Image size 1240x1240. Infant wide-field fundus photograph. Acquired on the Phoenix ICON — 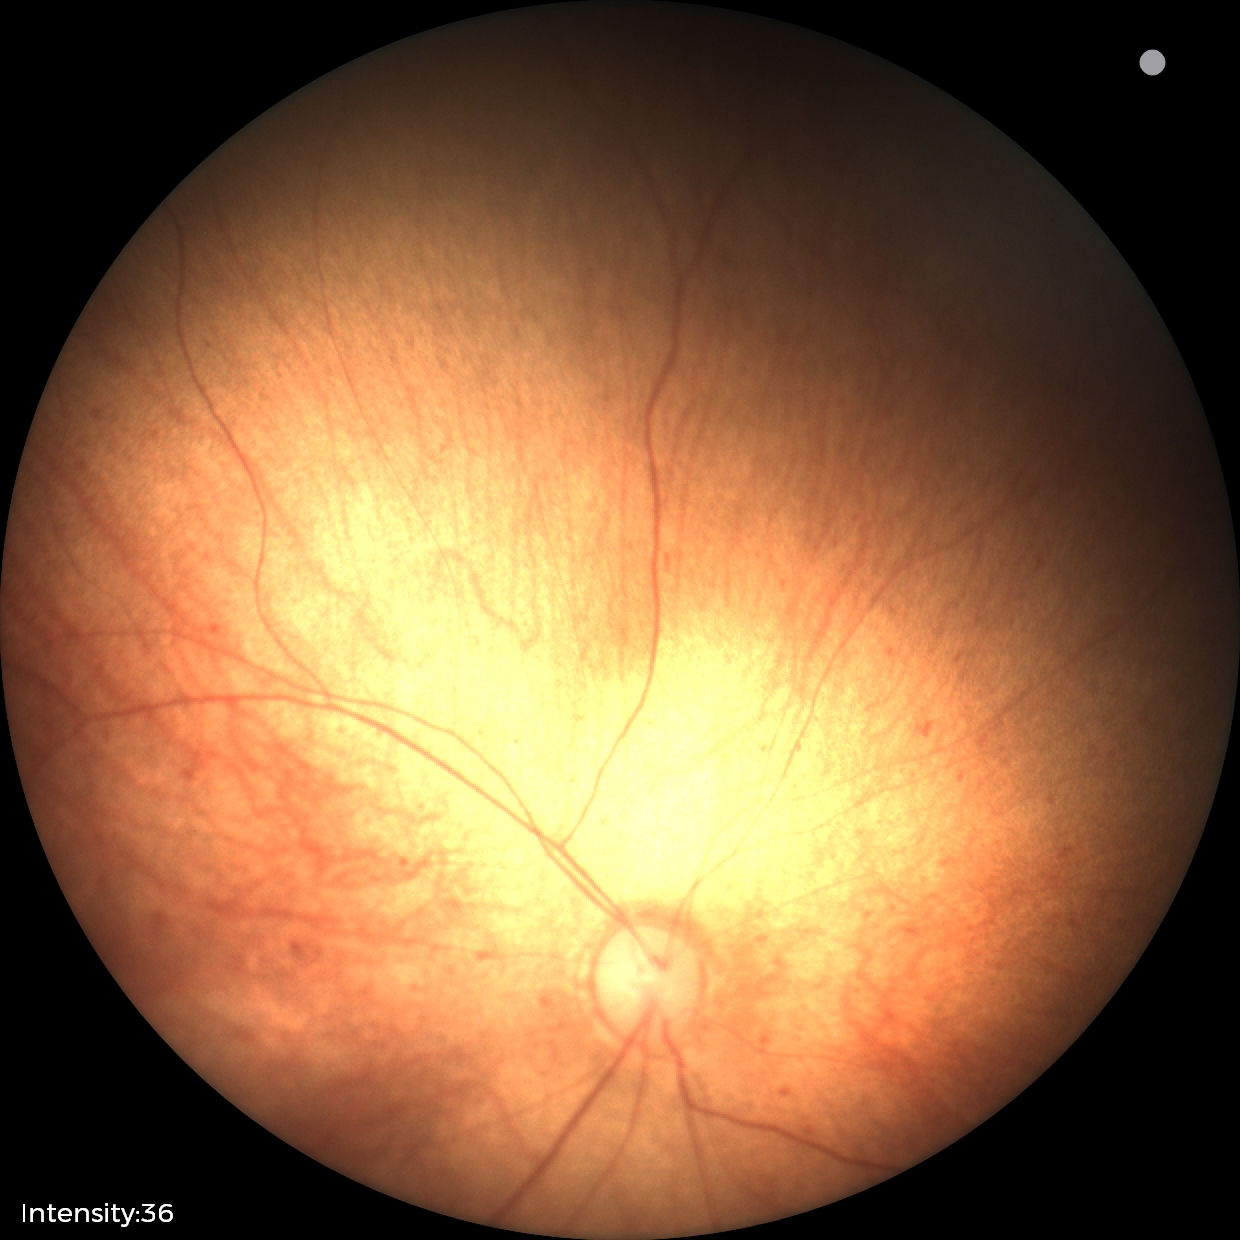
Examination with physiological retinal findings.